45° FOV. No pharmacologic dilation. Color fundus photograph — 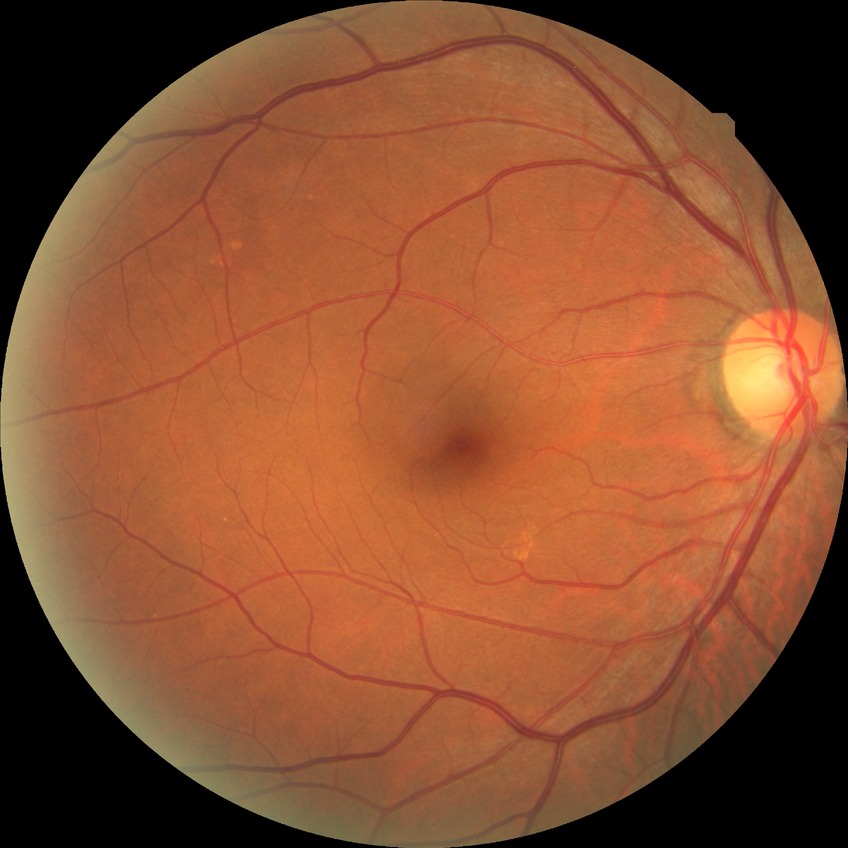
Modified Davis classification: no diabetic retinopathy.